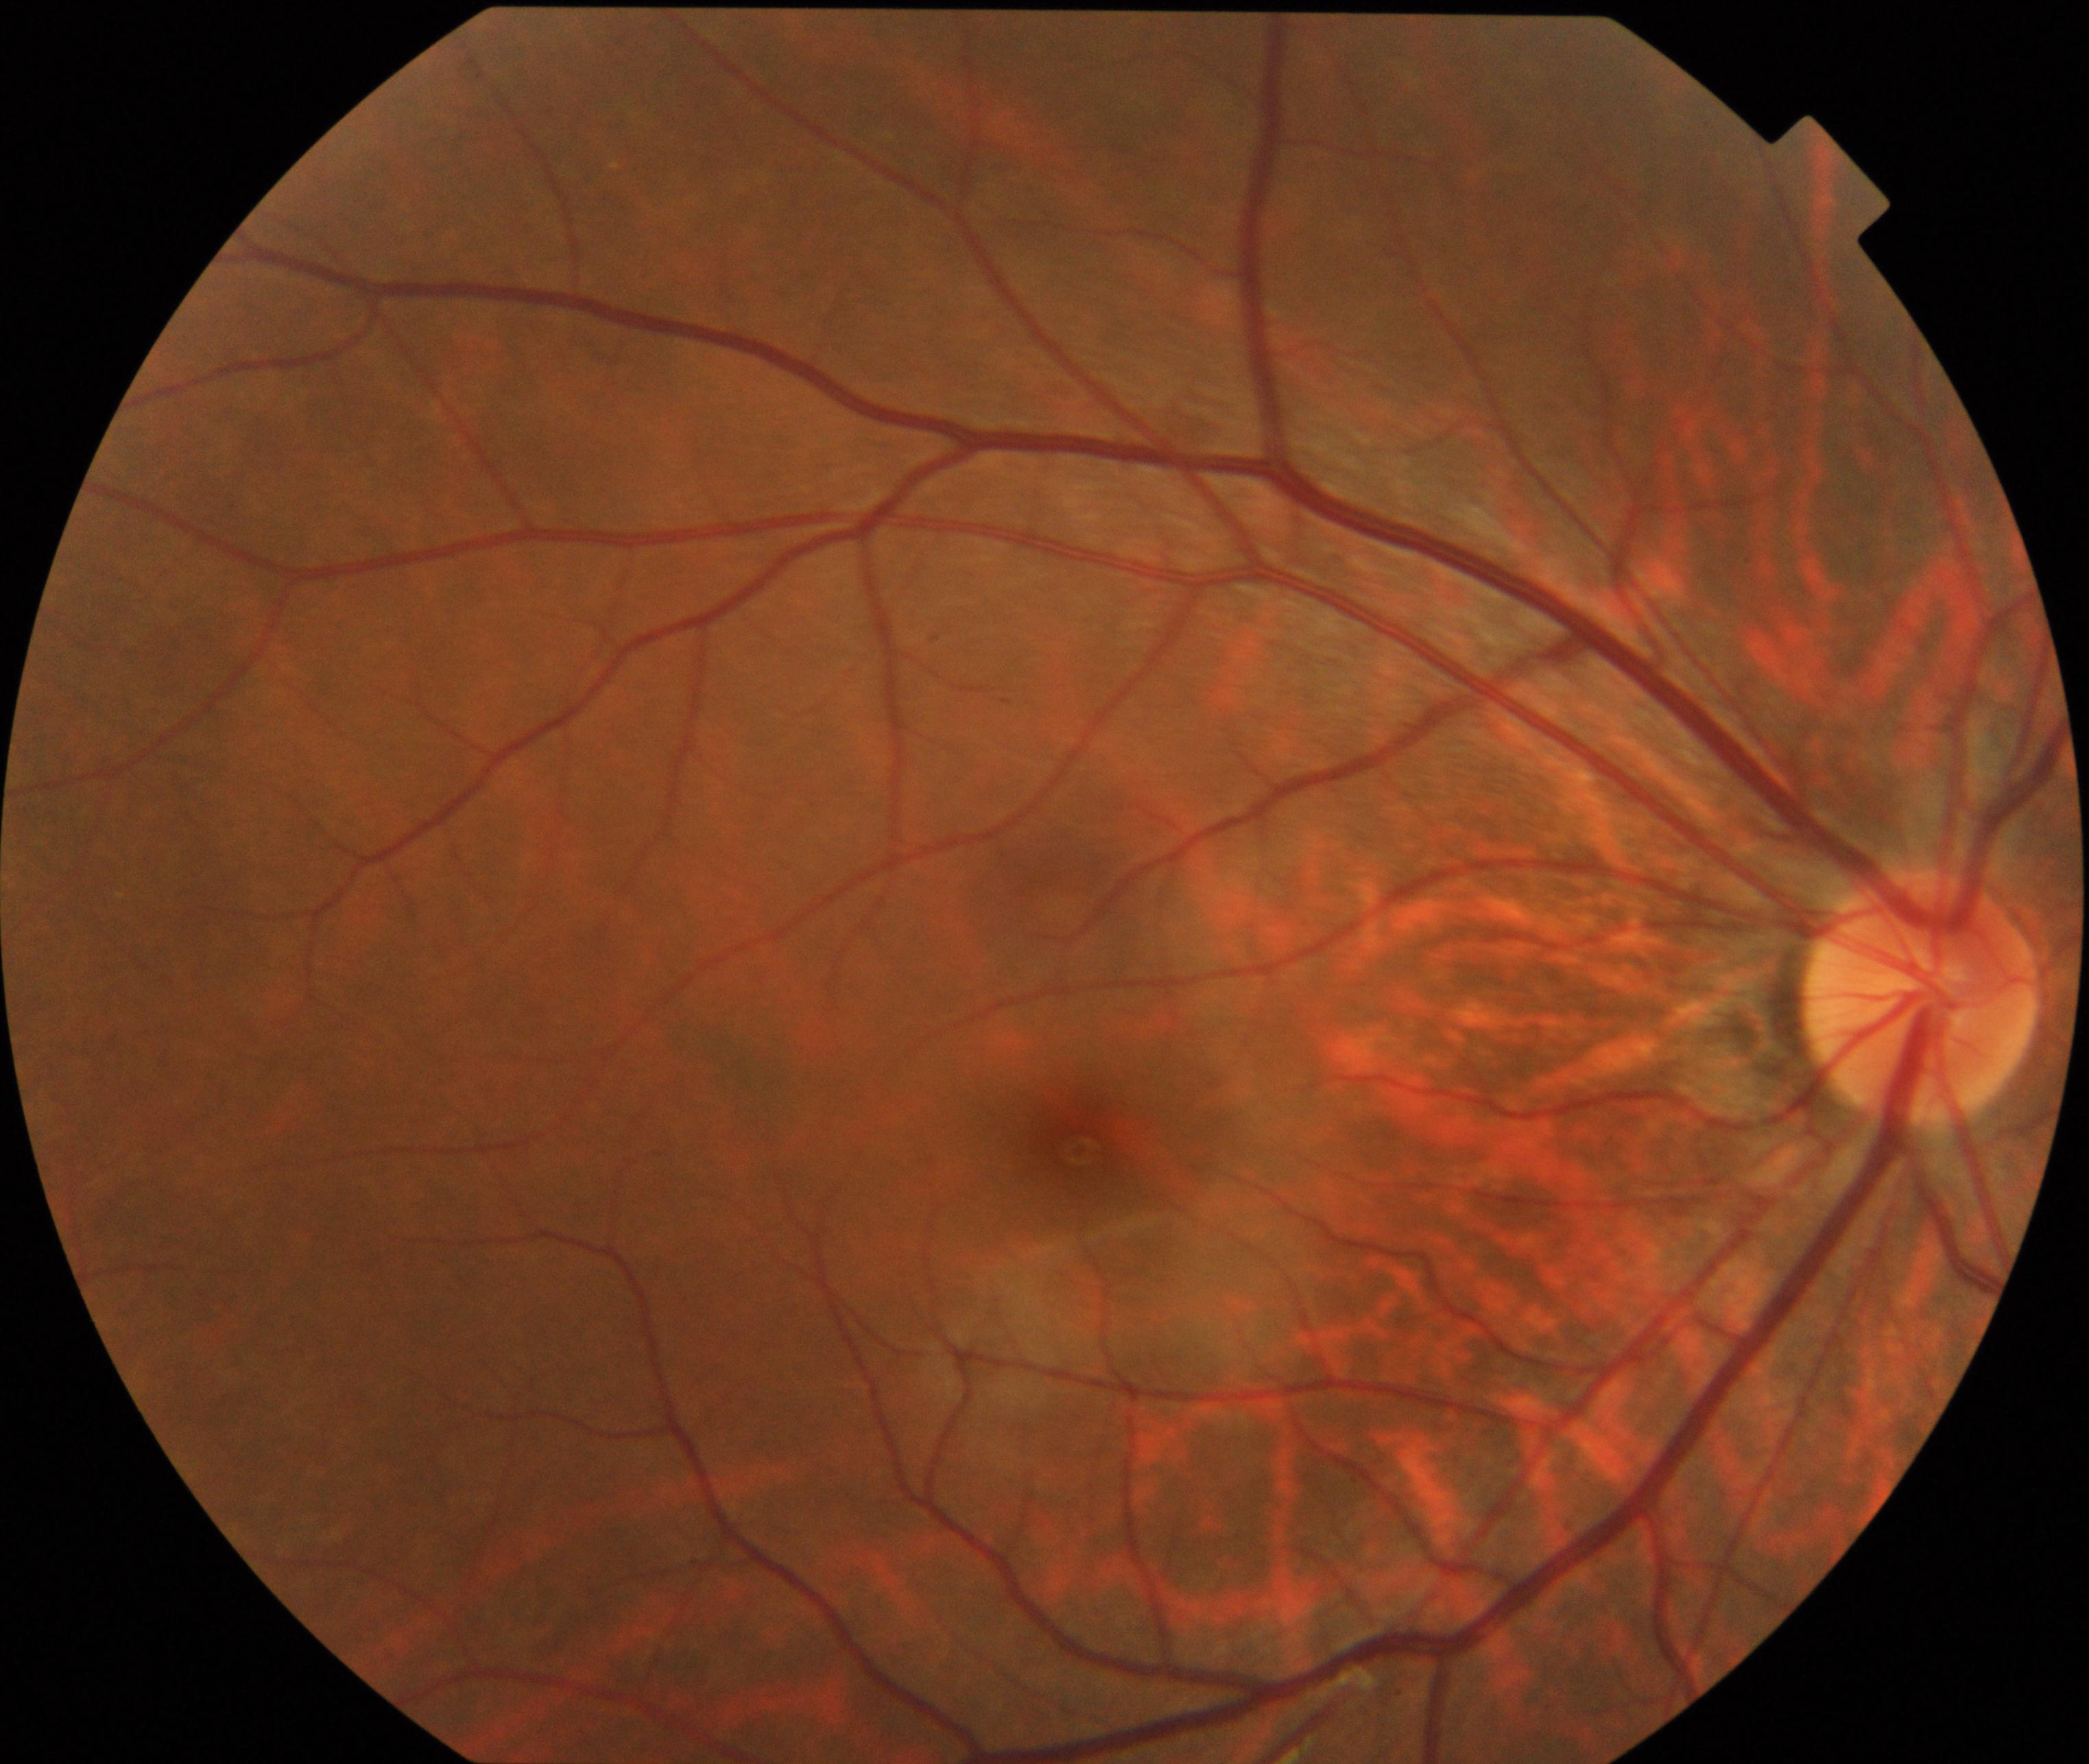 Retinal fundus photograph demonstrating tessellated fundus.